Acquired with a NIDEK AFC-230. 848x848. Color fundus image. 45° field of view: 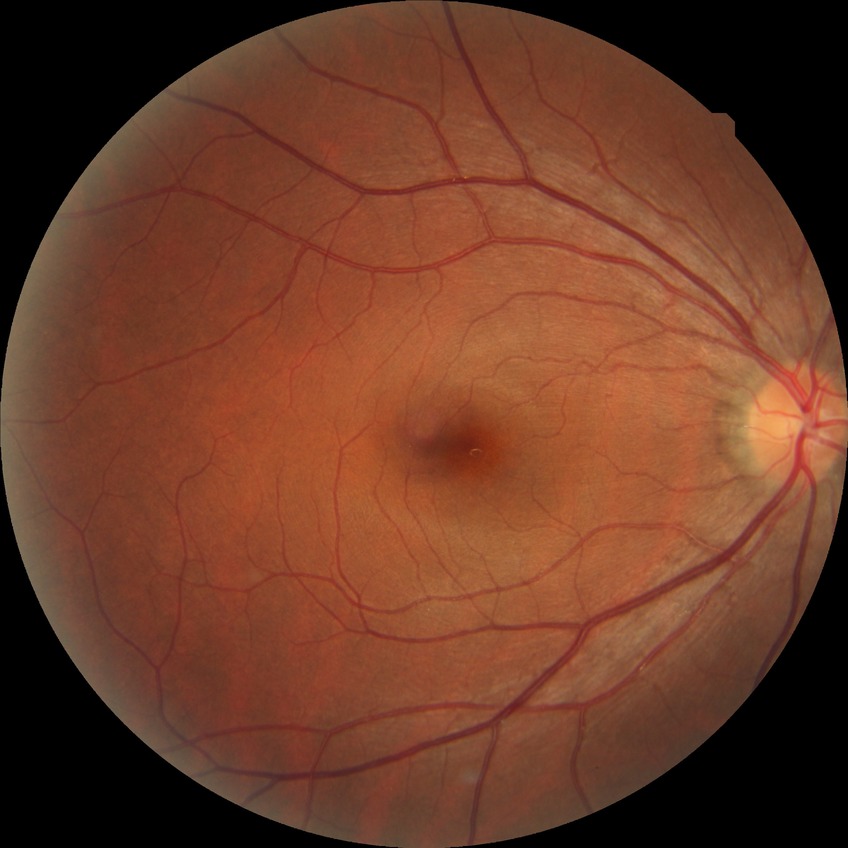
No diabetic retinal disease findings.
Davis stage is NDR.